Nonmydriatic, NIDEK AFC-230, 45 degree fundus photograph, 848x848px, retinal fundus photograph: 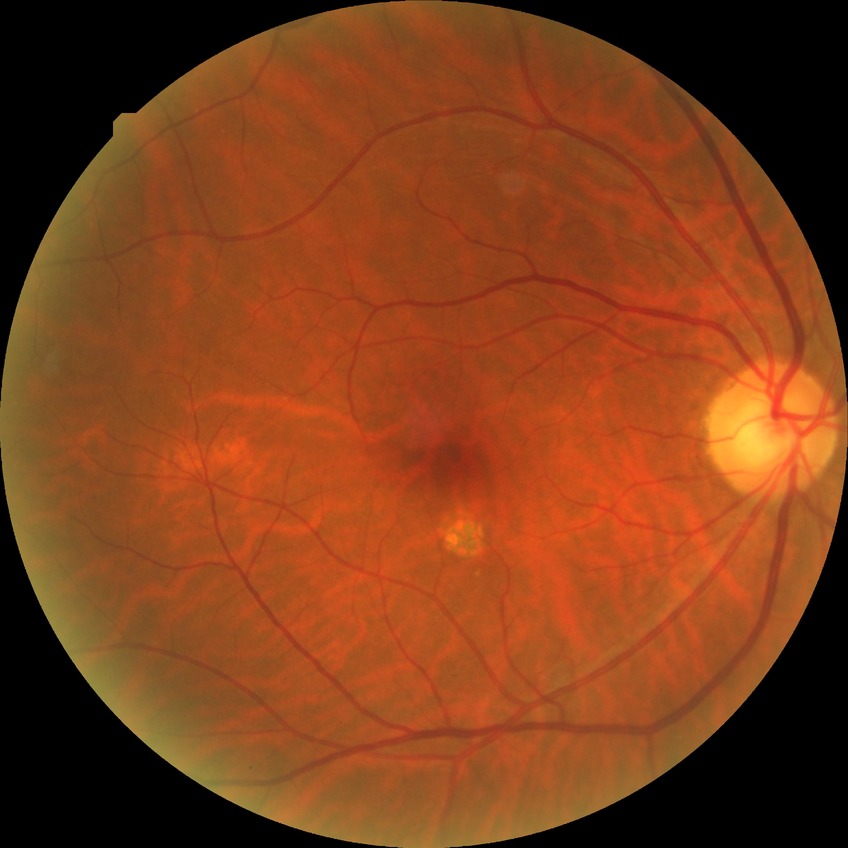 DR severity is NDR.